45° FOV. 2352 by 1568 pixels. CFP
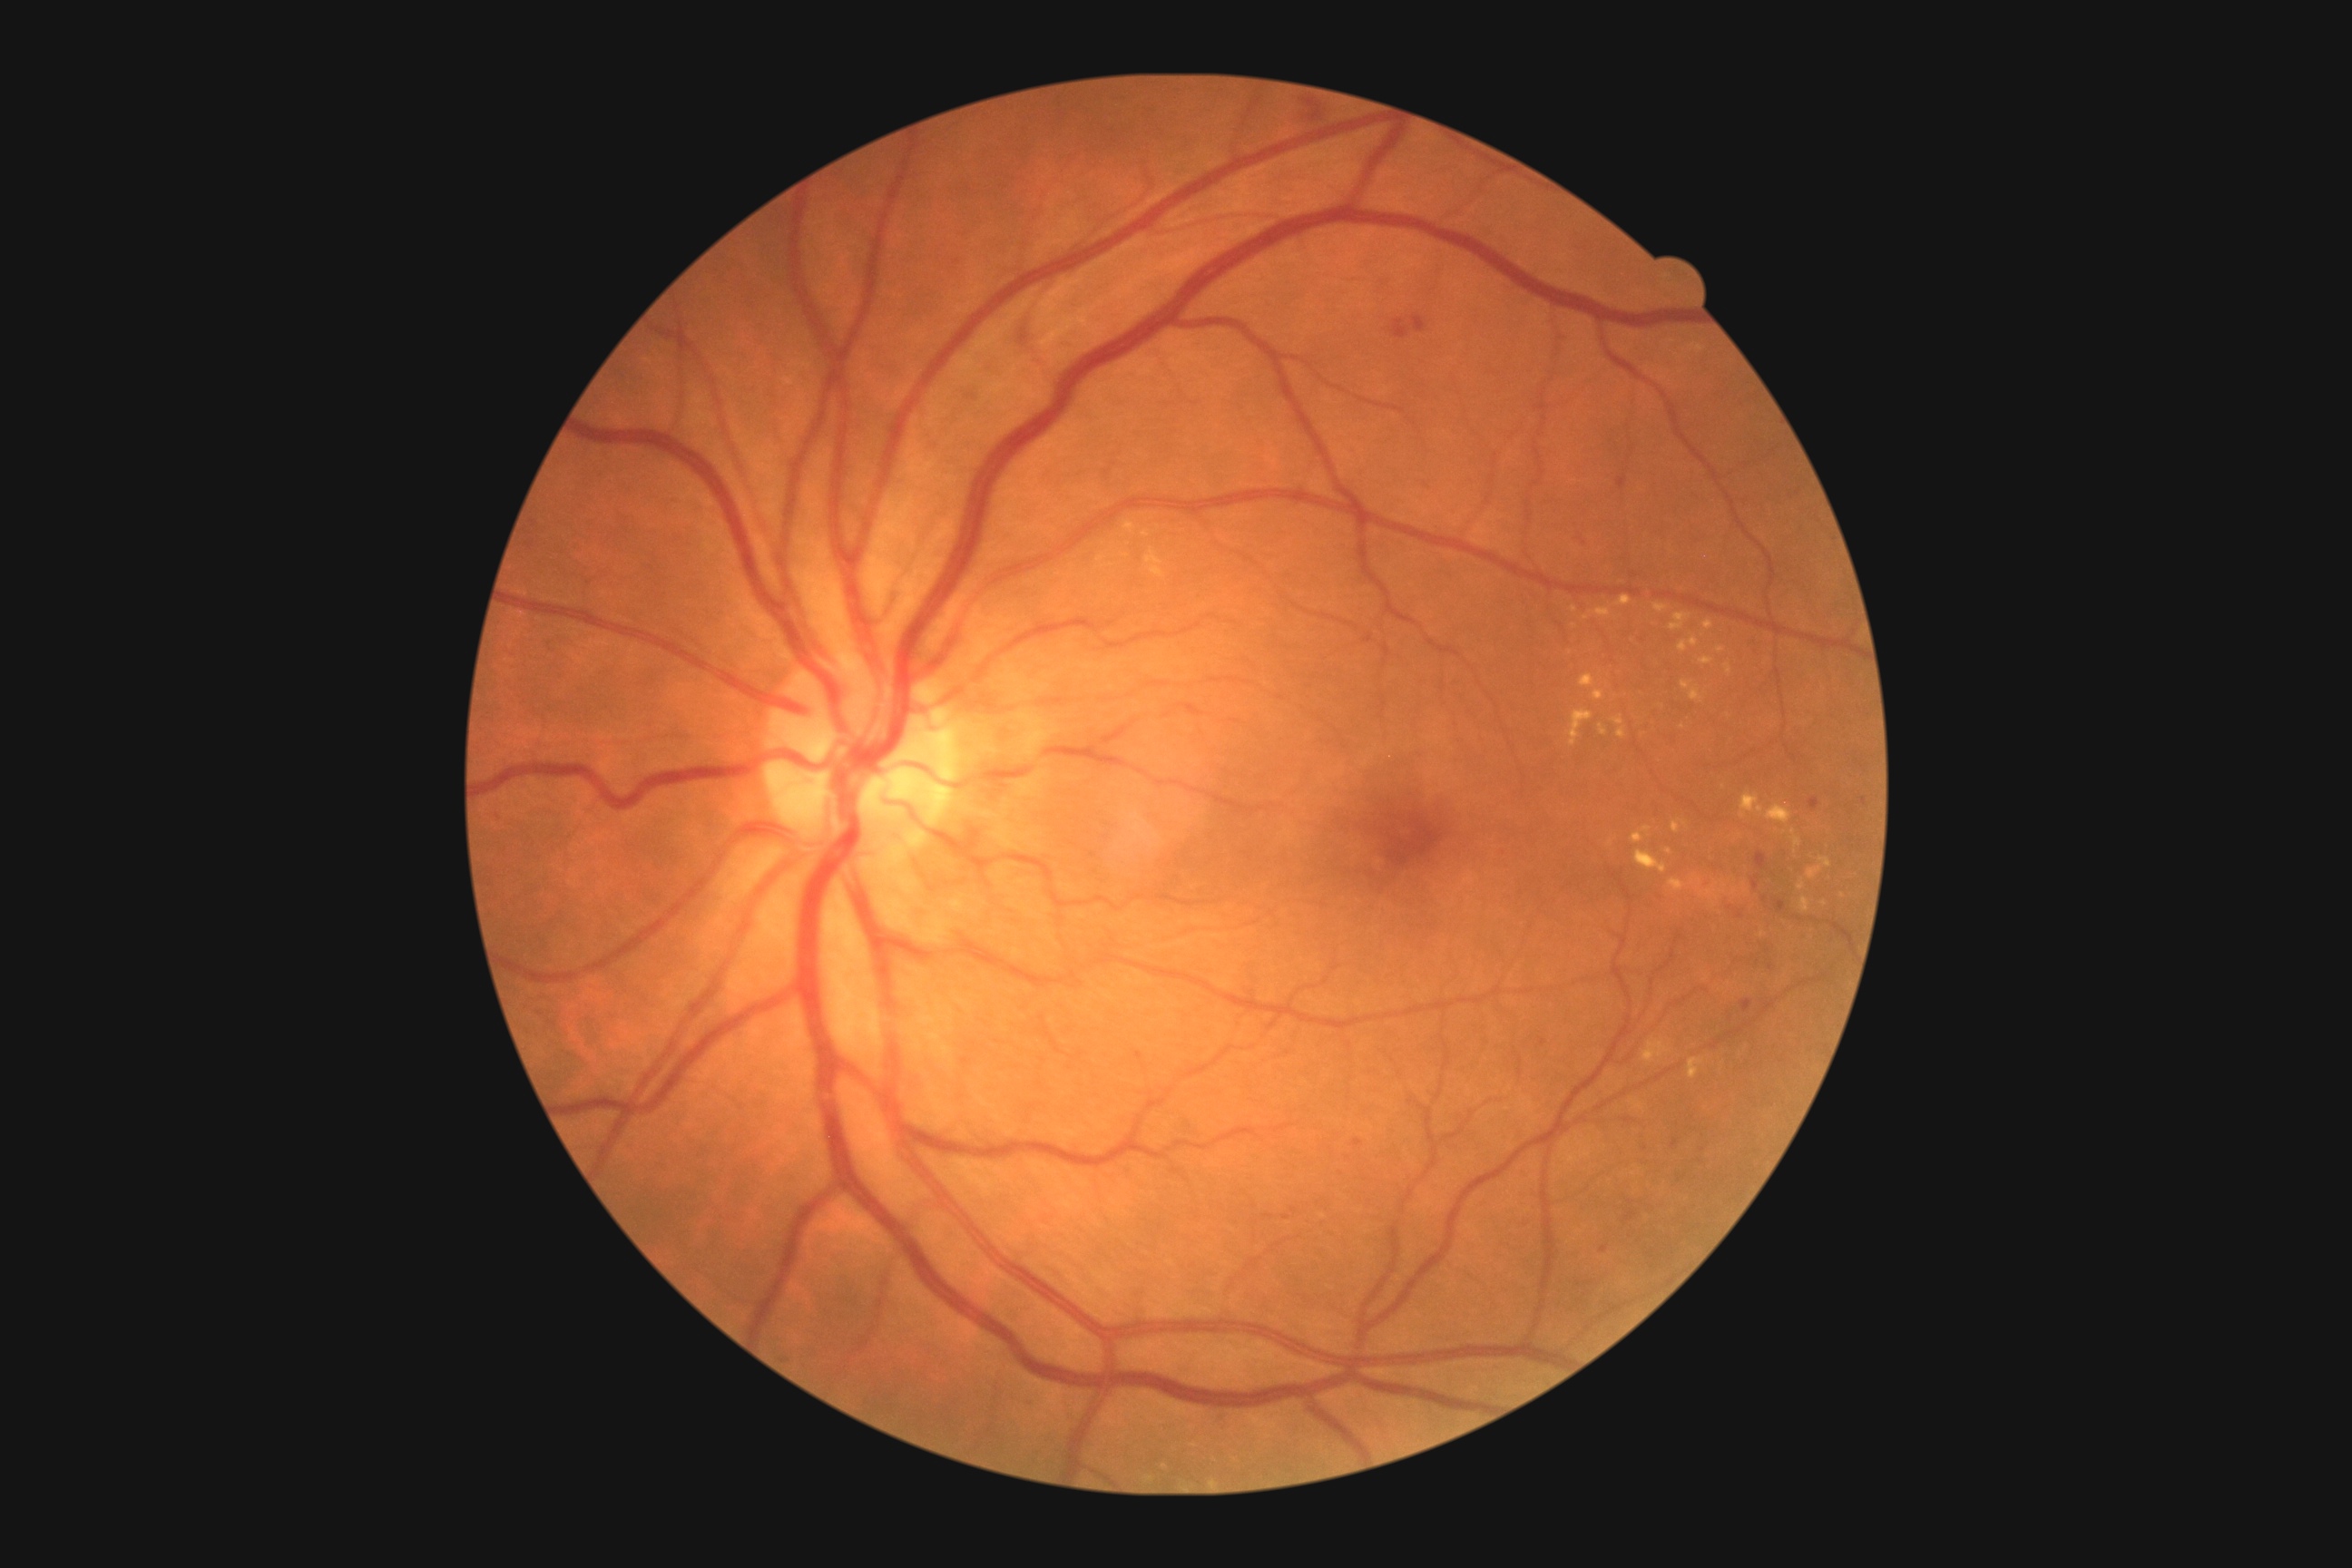

diabetic retinopathy (DR) = grade 2 (moderate NPDR) — more than just microaneurysms but less than severe NPDR